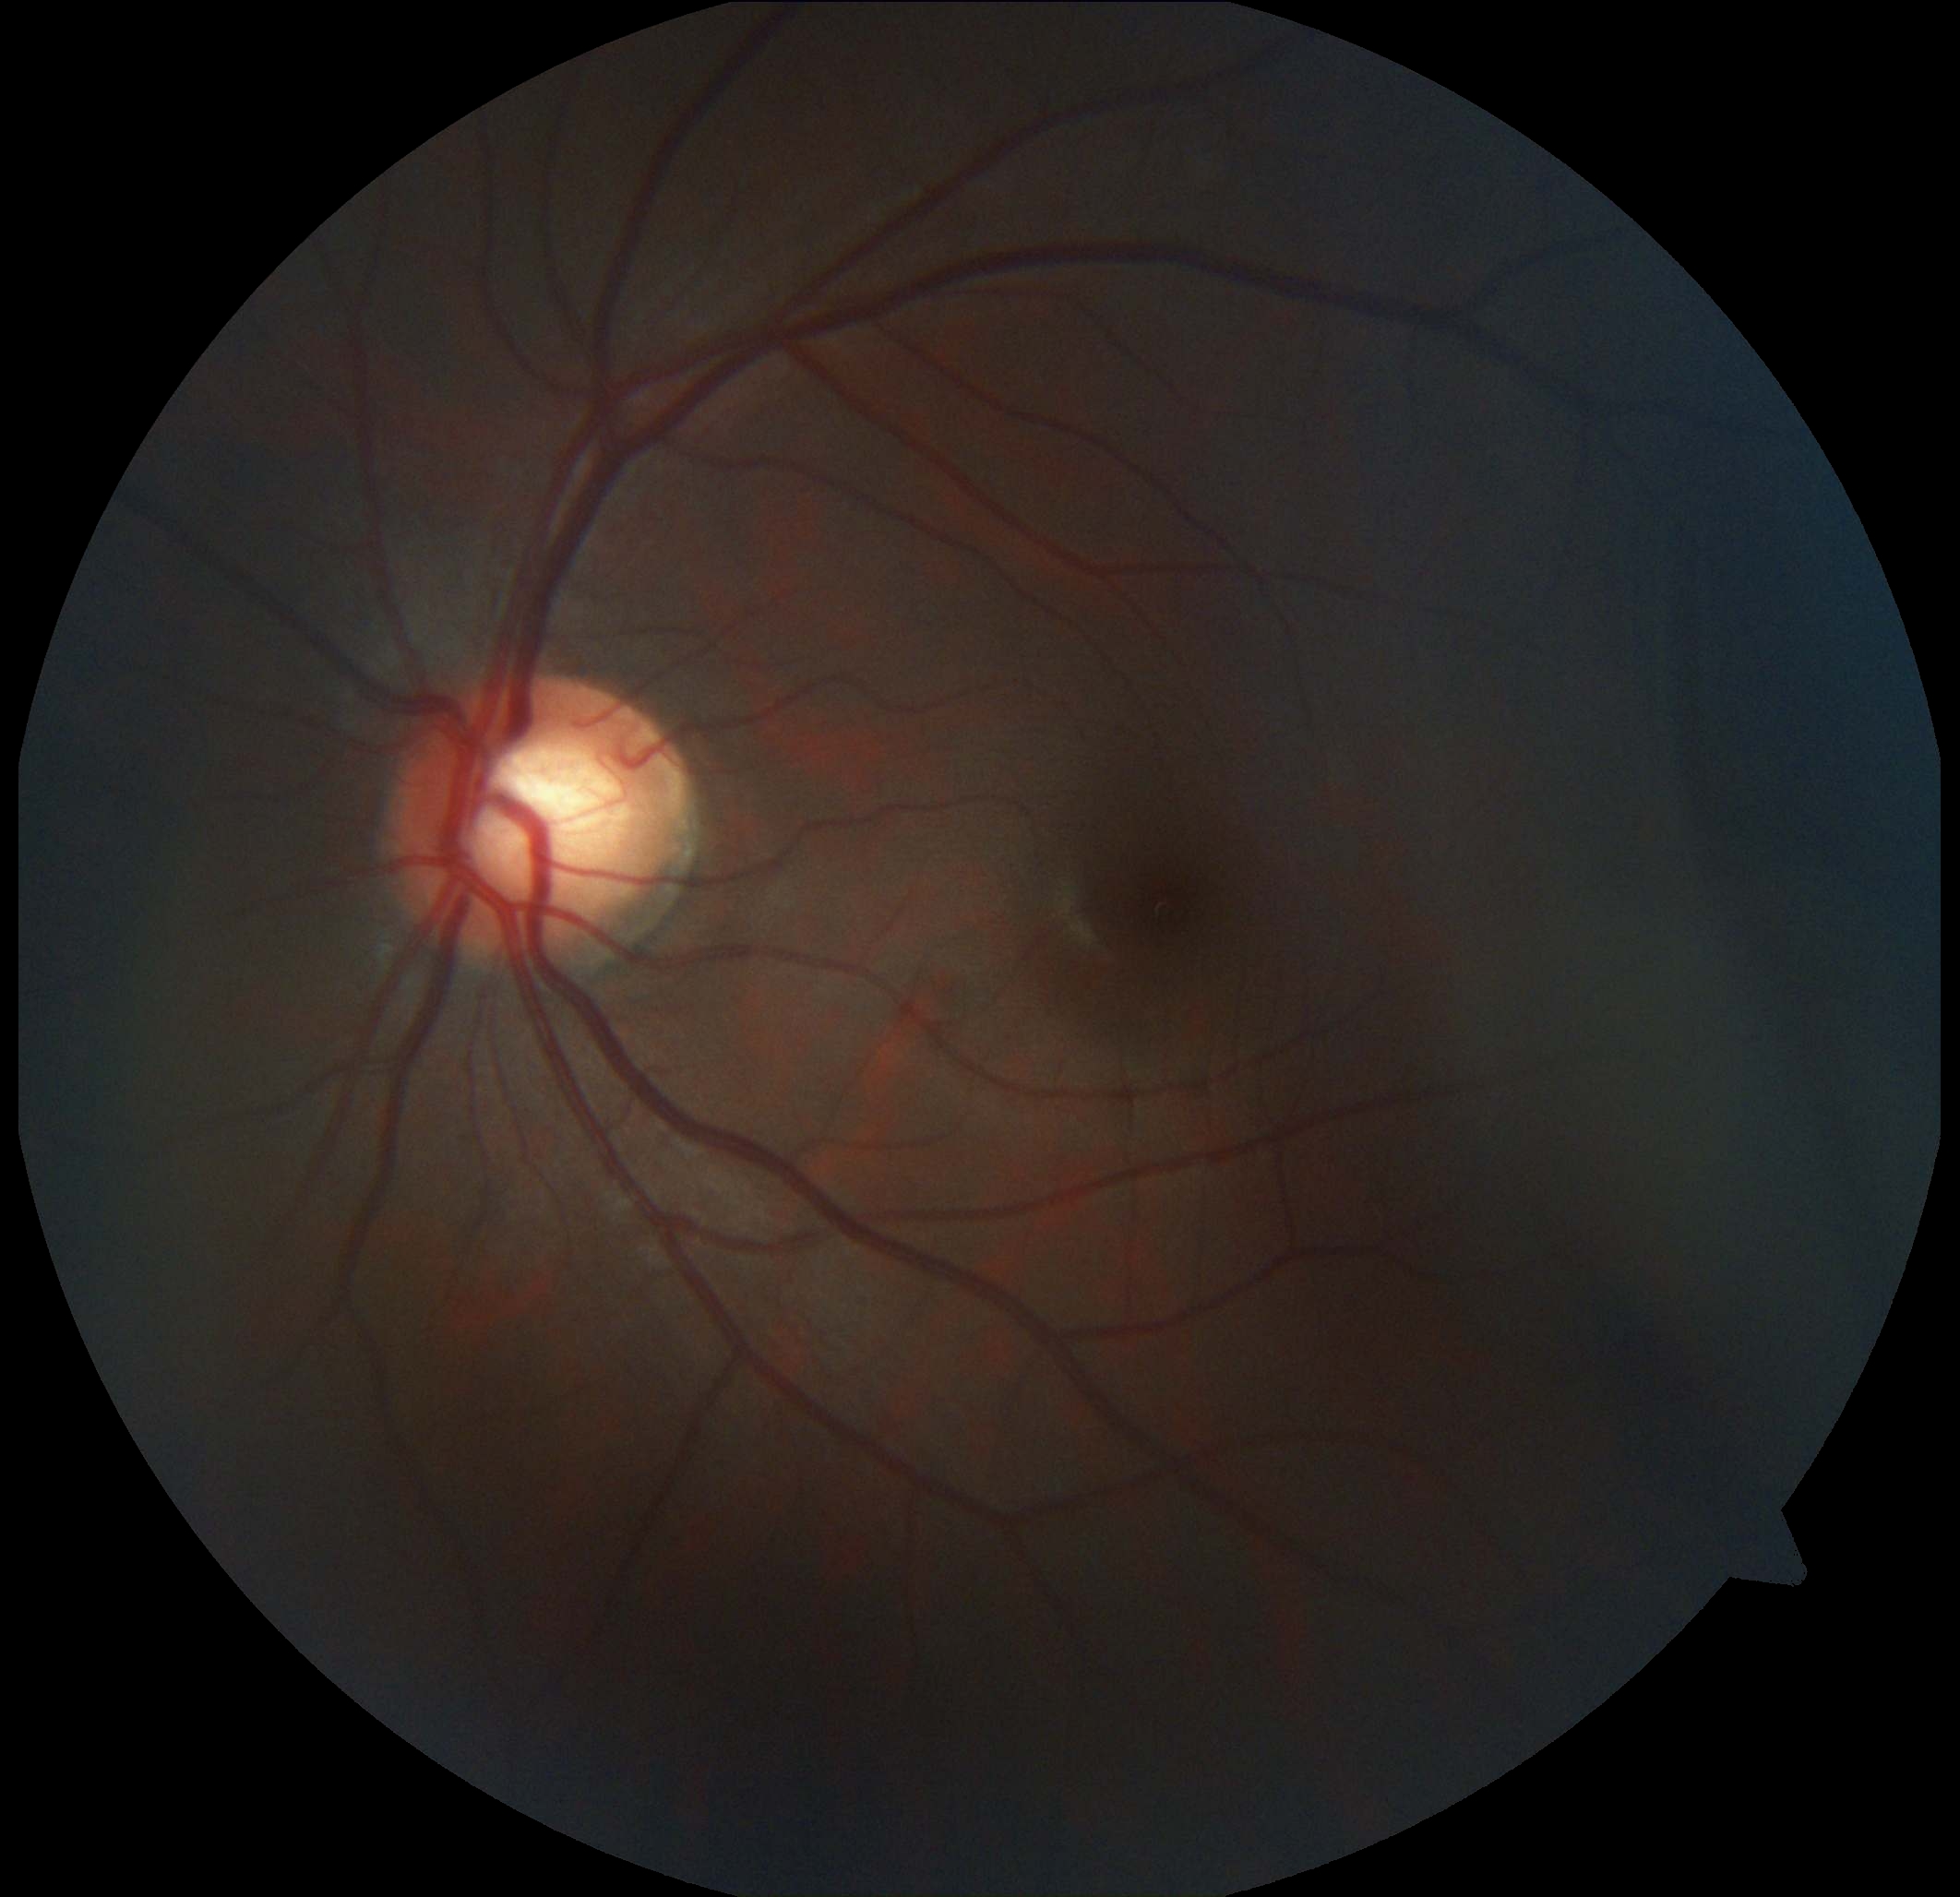
Diabetic retinopathy (DR): grade 0.